ONH-centered crop from a color fundus image: 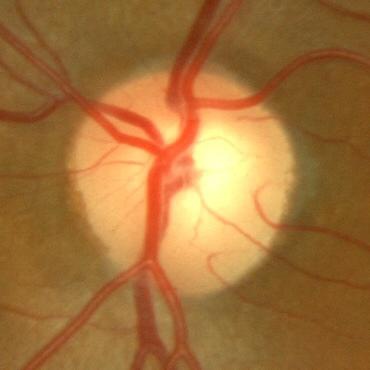 Demonstrates no signs of glaucoma.